Captured with the Phoenix ICON (100° field of view) · wide-field fundus photograph of an infant
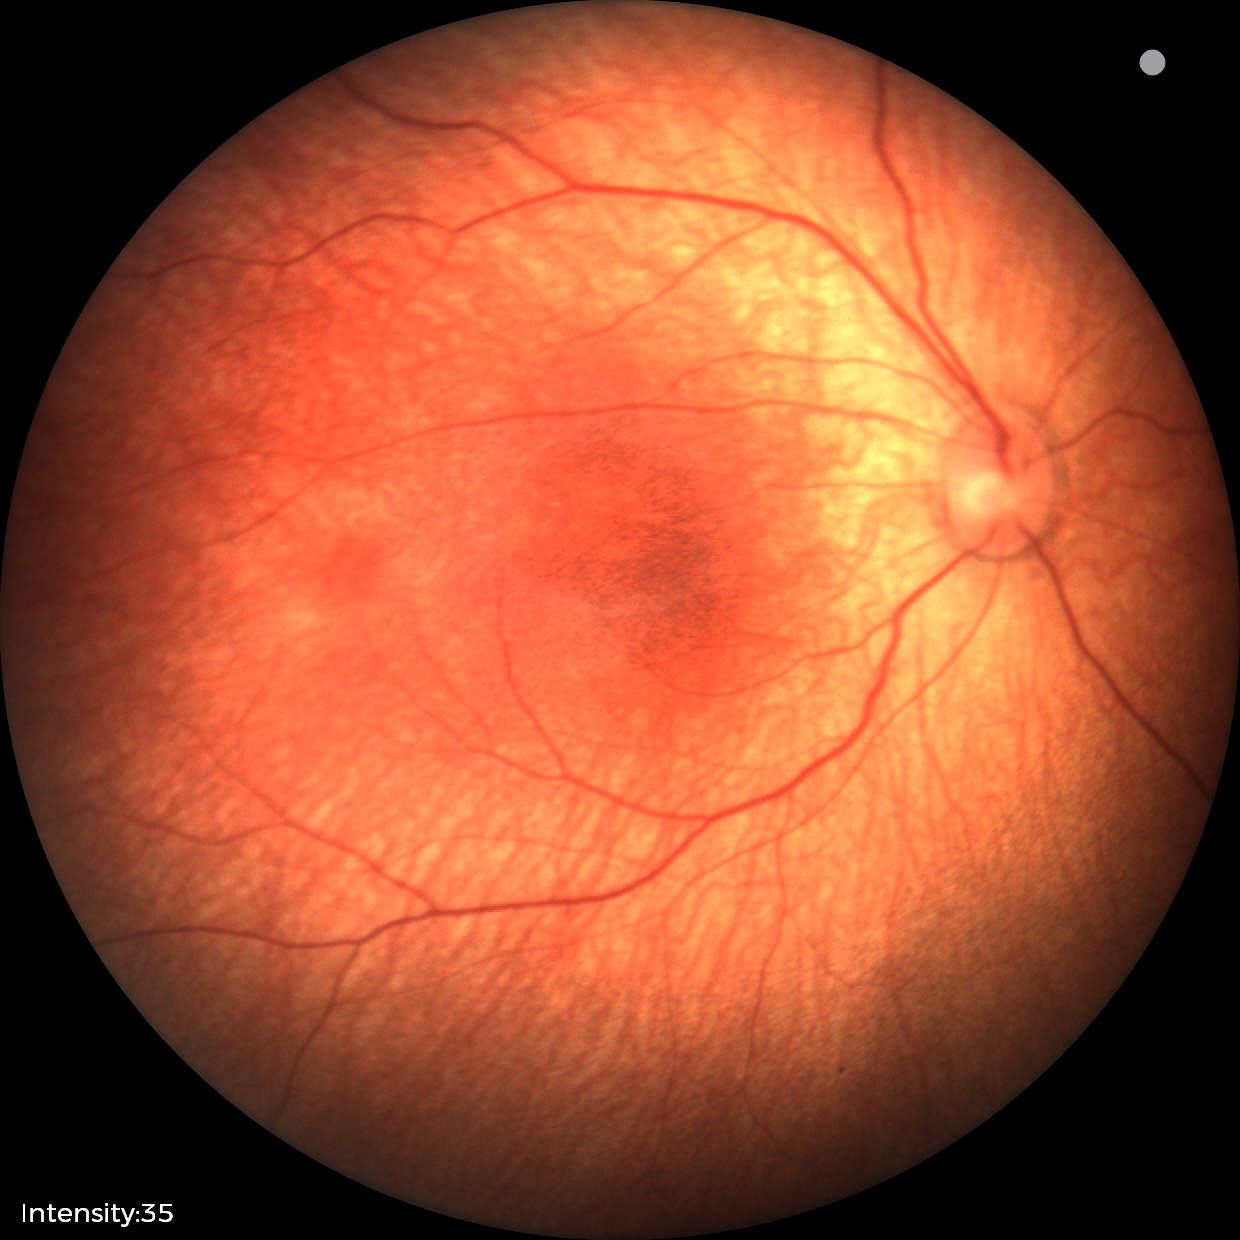
Physiological retinal appearance for postconceptual age.